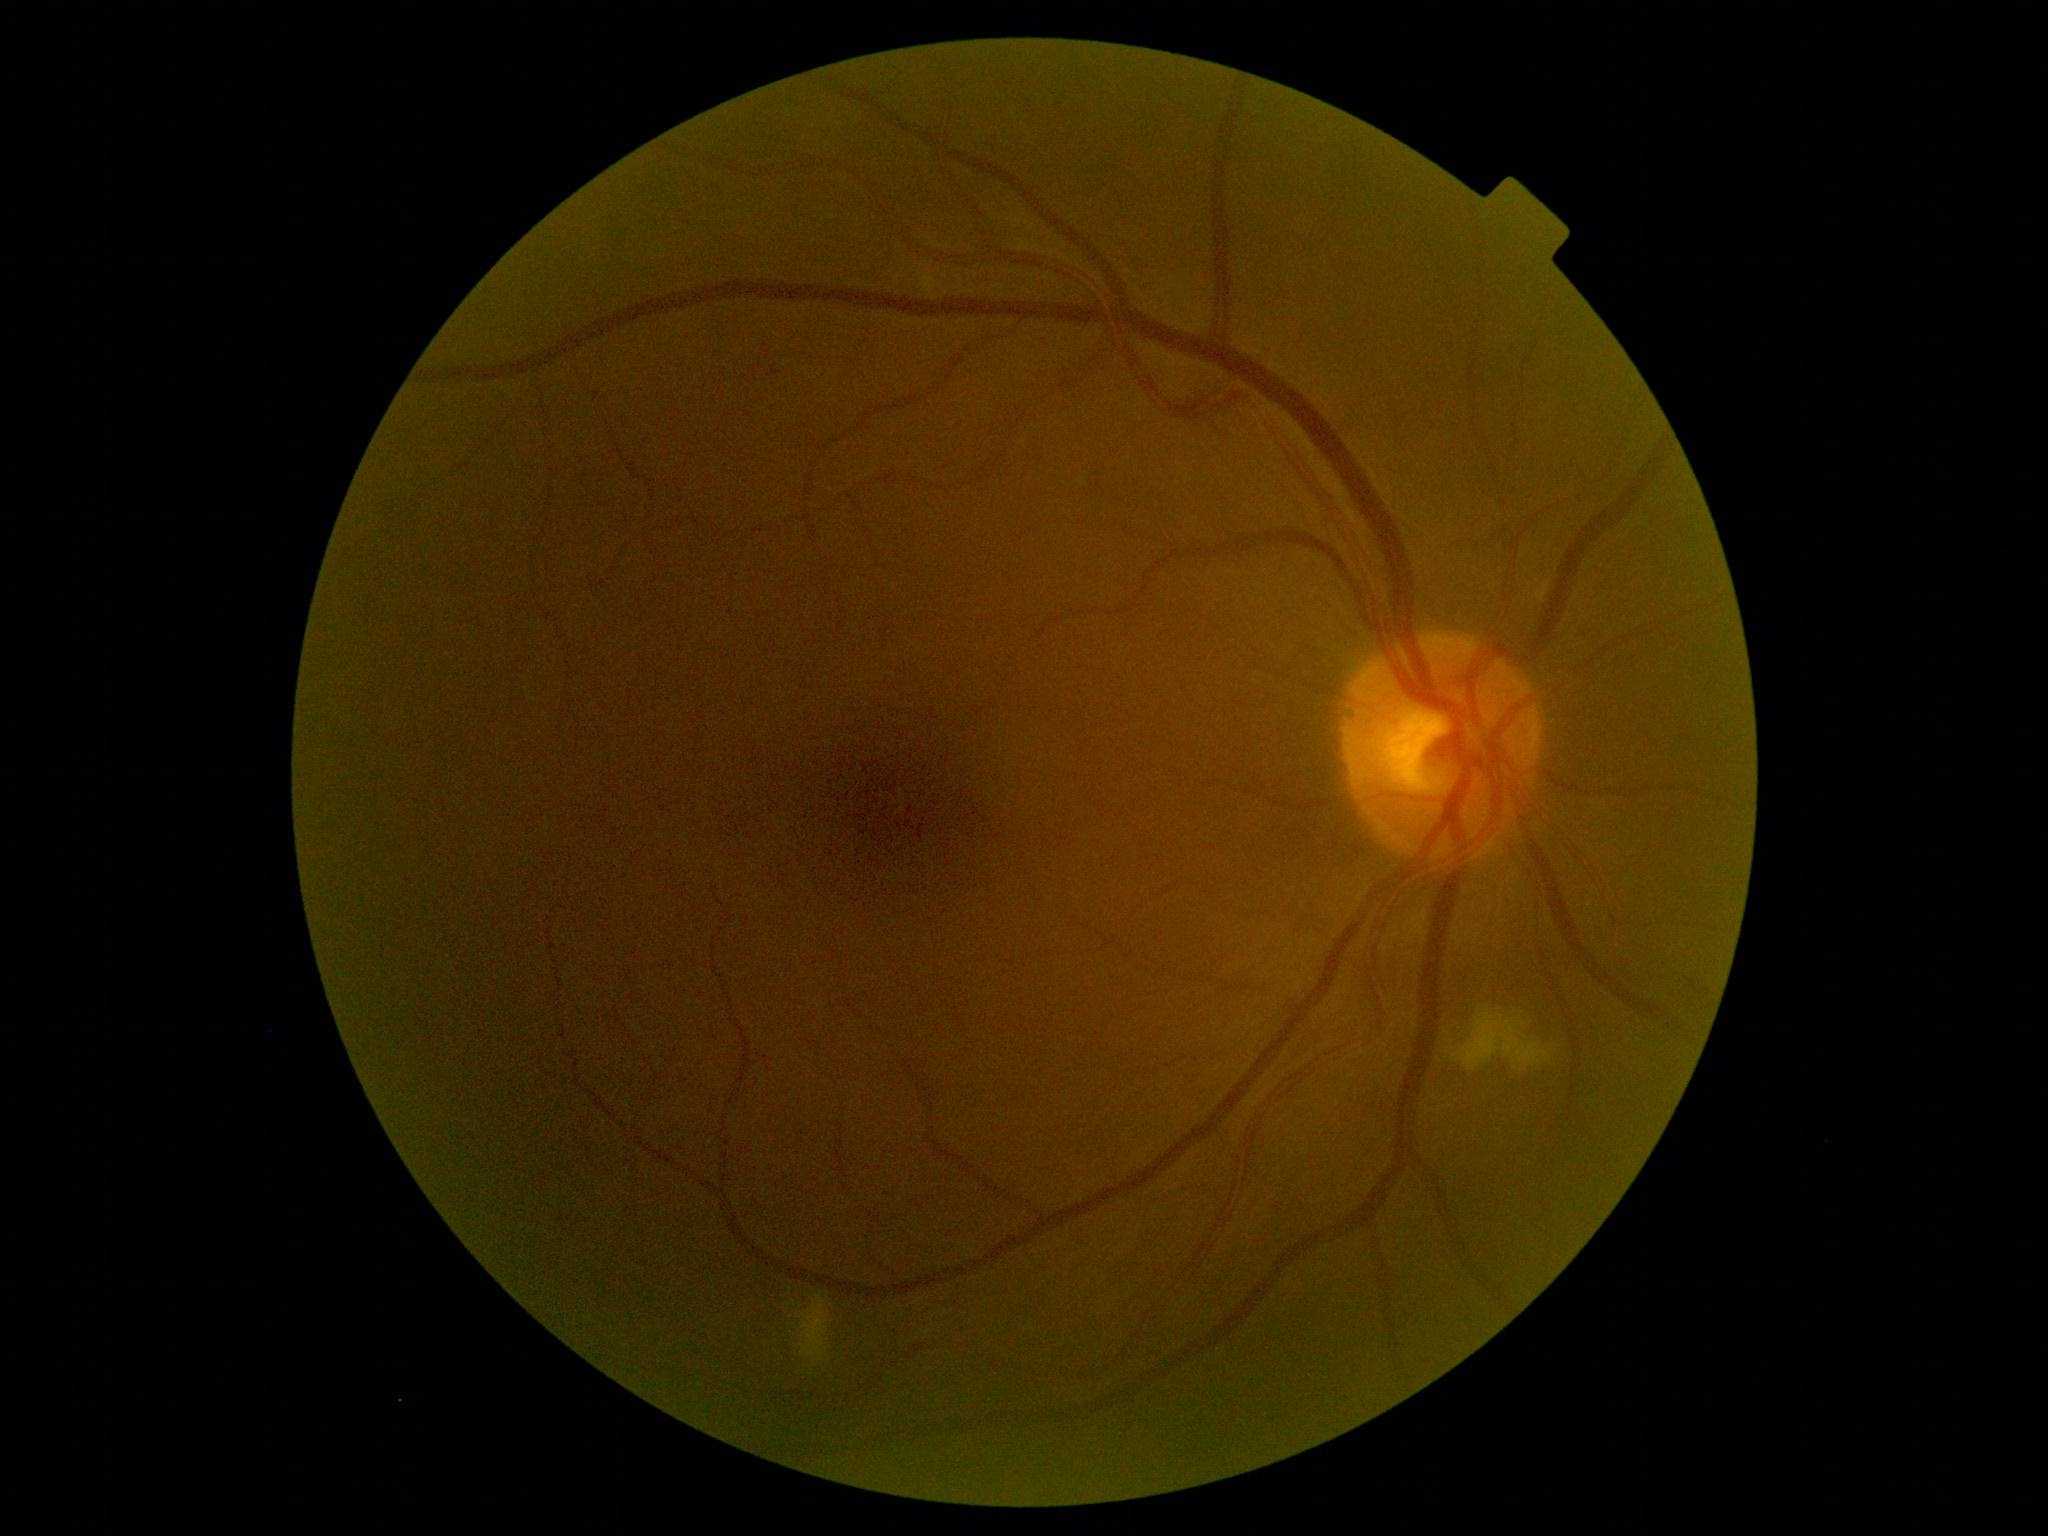
Diabetic retinopathy (DR): grade 2 (moderate NPDR).